Fundus photo. FOV: 45 degrees. 848x848.
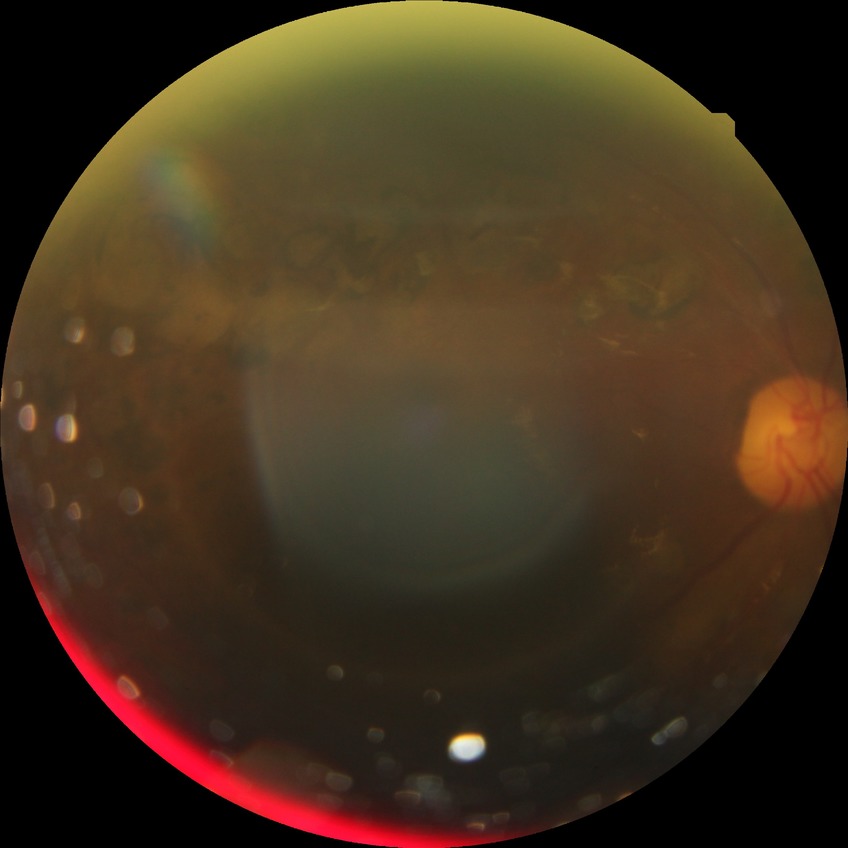
diabetic retinopathy (DR)=PDR (proliferative diabetic retinopathy).